Color fundus photograph:
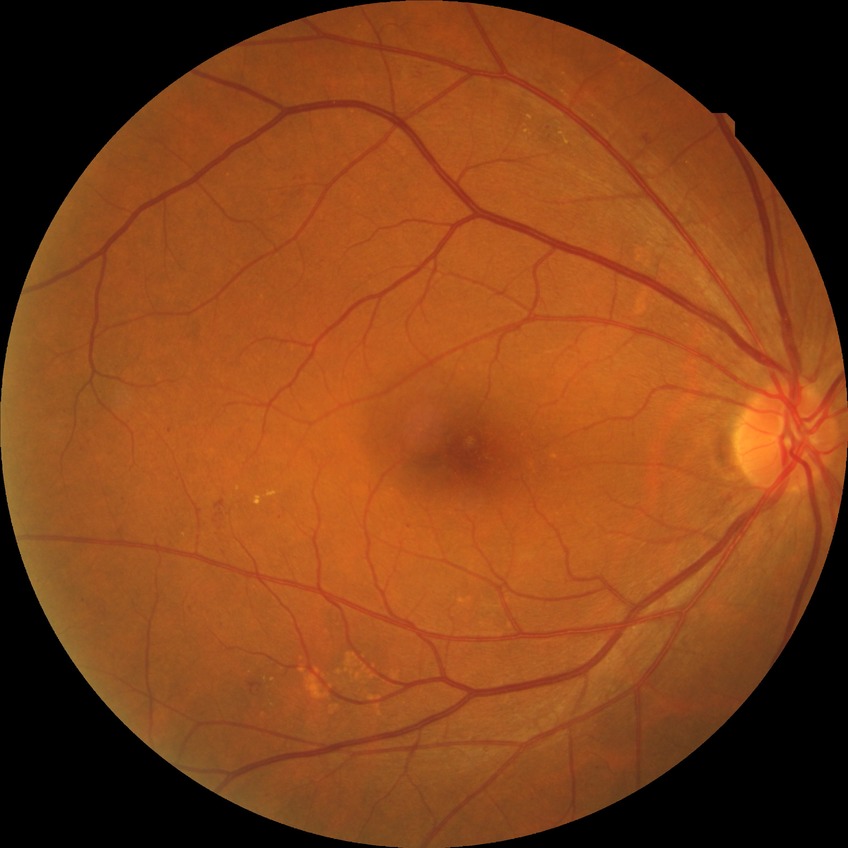
Disease class: non-proliferative diabetic retinopathy. DR is SDR.